No pharmacologic dilation; posterior pole photograph; NIDEK AFC-230.
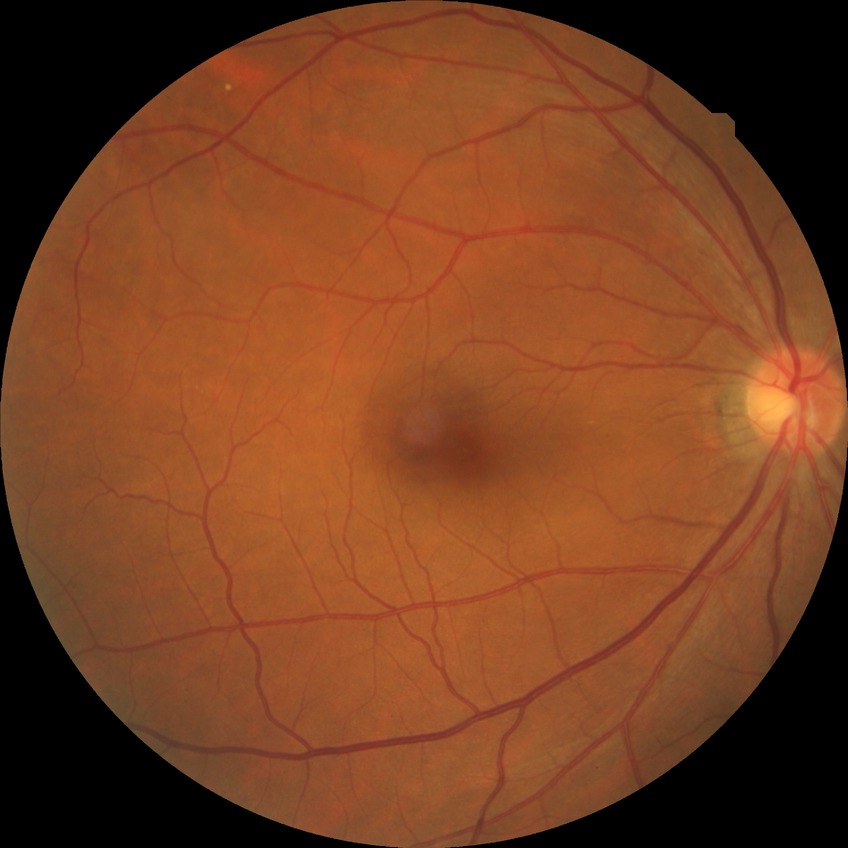
DR severity: NDR.